FOV: 45 degrees:
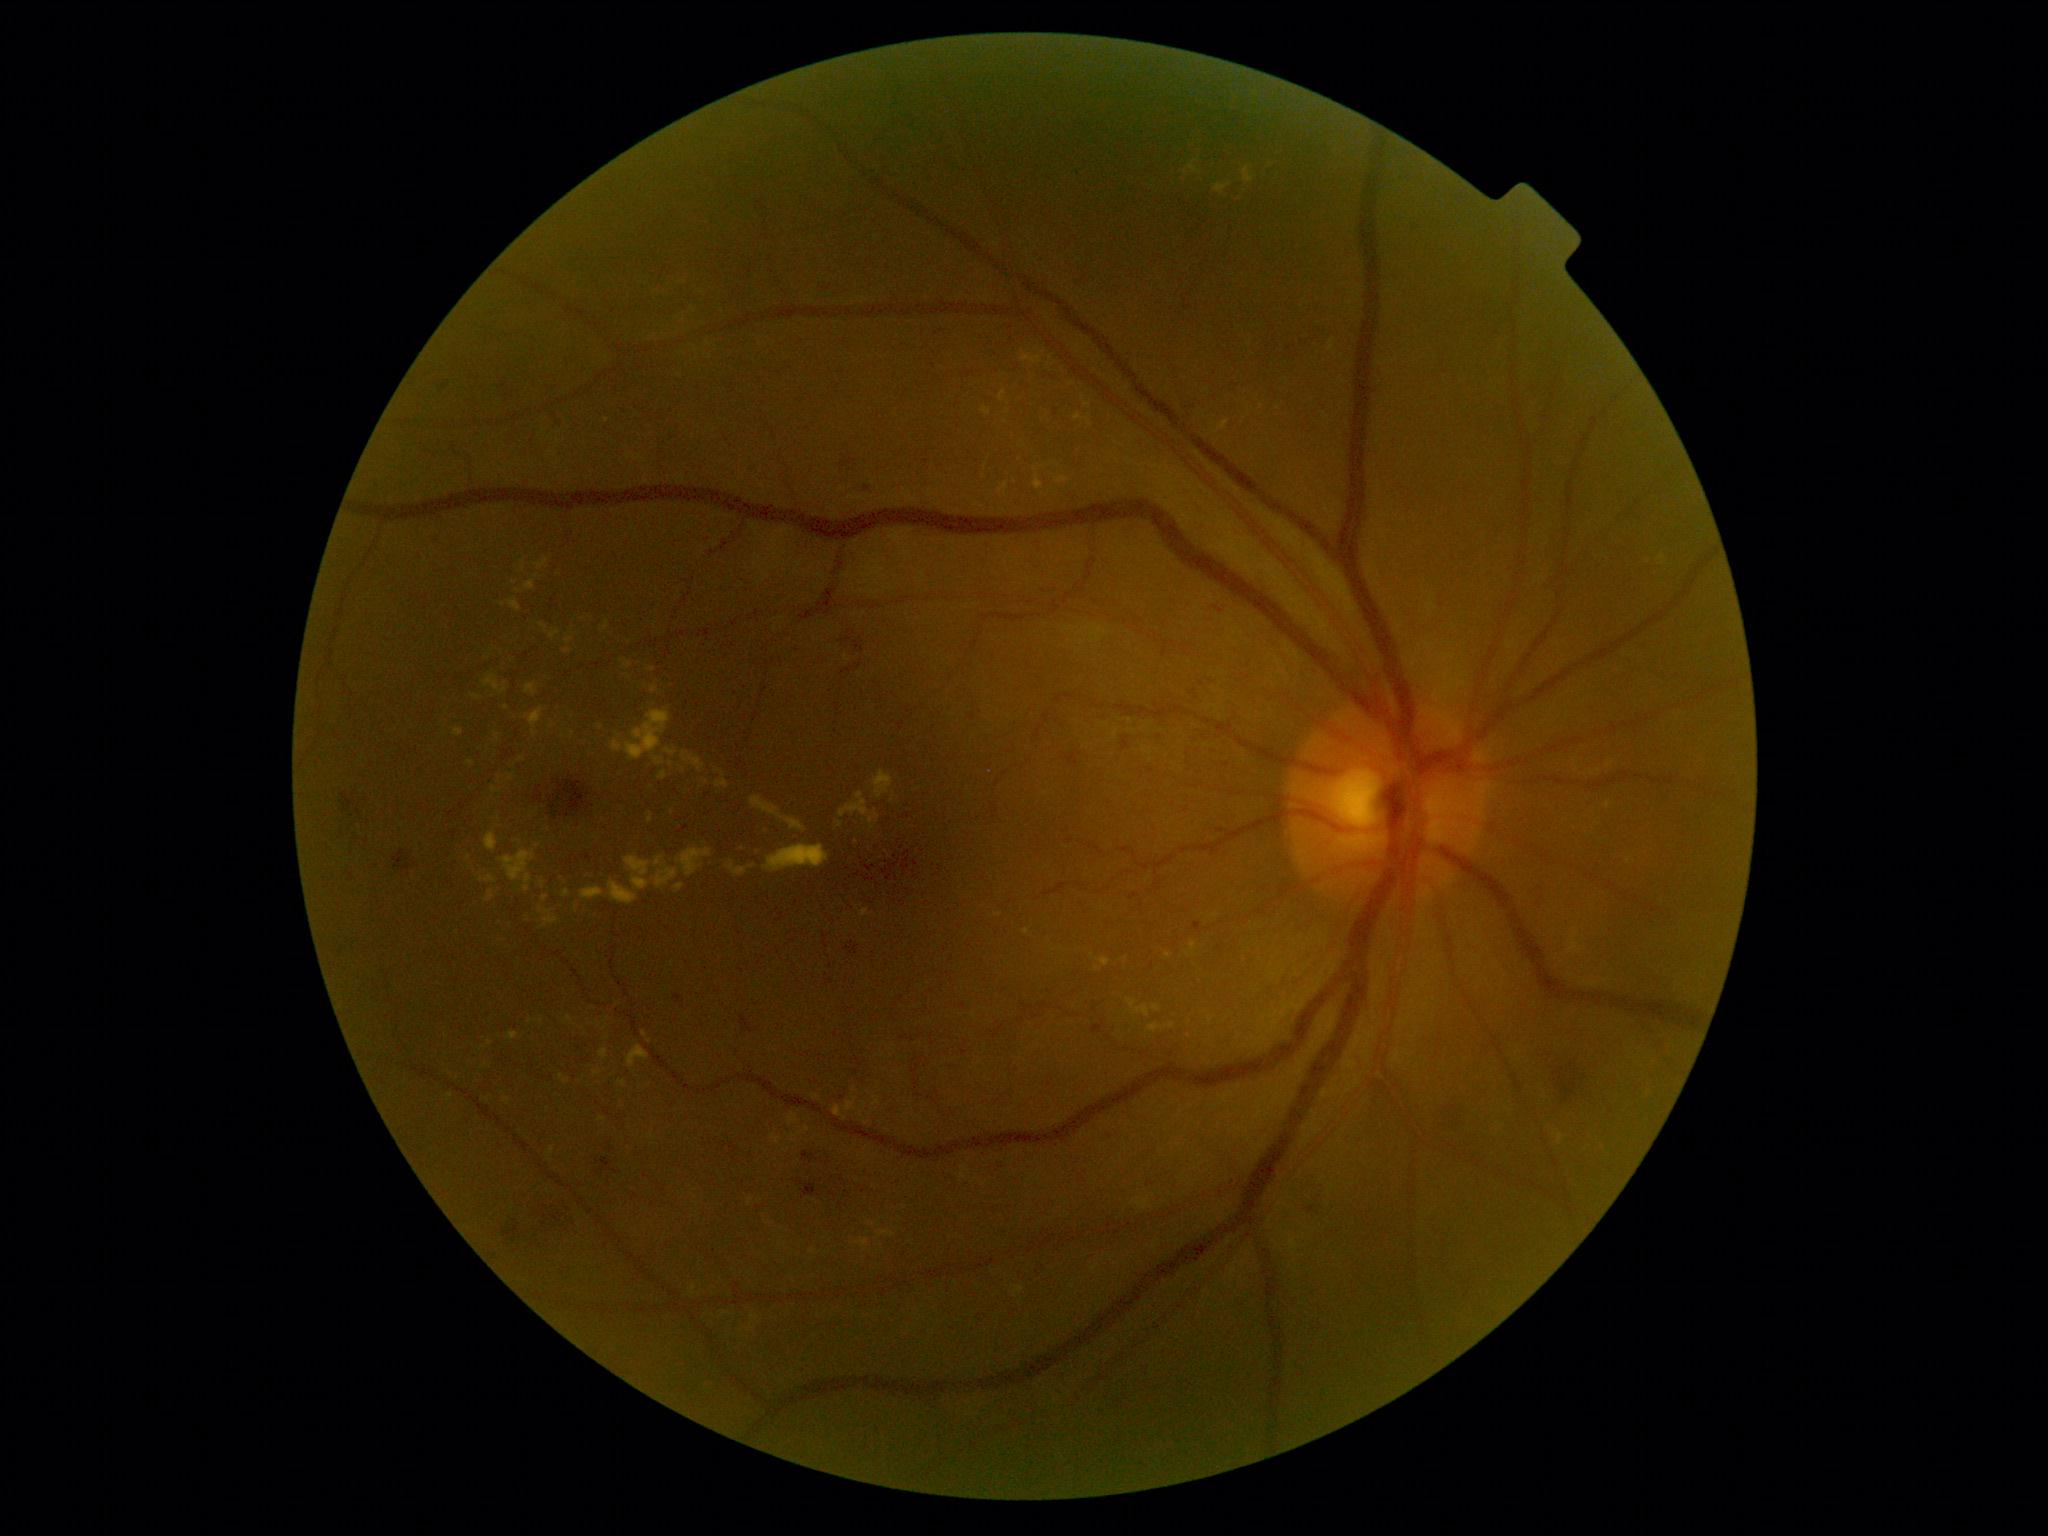
Diabetic retinopathy (DR): moderate NPDR (grade 2)
Representative lesions:
hemorrhages (HEs) (continued): (left=846, top=942, right=859, bottom=955); (left=1526, top=885, right=1554, bottom=912); (left=1130, top=893, right=1138, bottom=901); (left=842, top=667, right=853, bottom=674); (left=1294, top=1181, right=1330, bottom=1226); (left=548, top=411, right=565, bottom=432); (left=842, top=460, right=856, bottom=467); (left=1216, top=828, right=1233, bottom=836); (left=1065, top=752, right=1080, bottom=769); (left=992, top=1157, right=1015, bottom=1174); (left=1534, top=1044, right=1597, bottom=1113); (left=856, top=481, right=885, bottom=498)
Small HEs near (970,374); (858,666); (1290,349)
microaneurysms (MAs): none identified
hard exudates (EXs) (continued): (left=658, top=770, right=668, bottom=780); (left=860, top=909, right=870, bottom=916); (left=749, top=1198, right=753, bottom=1206); (left=1165, top=954, right=1173, bottom=959); (left=1186, top=941, right=1197, bottom=958); (left=594, top=1070, right=602, bottom=1077); (left=655, top=856, right=678, bottom=889); (left=1148, top=1024, right=1163, bottom=1034); (left=653, top=756, right=665, bottom=766); (left=1127, top=998, right=1151, bottom=1017); (left=1190, top=156, right=1273, bottom=202); (left=540, top=623, right=548, bottom=633)
Small EXs near (539,845); (865,1122); (570,1018); (531,1021); (629,677); (854,1089)
soft exudates (SEs): none identified